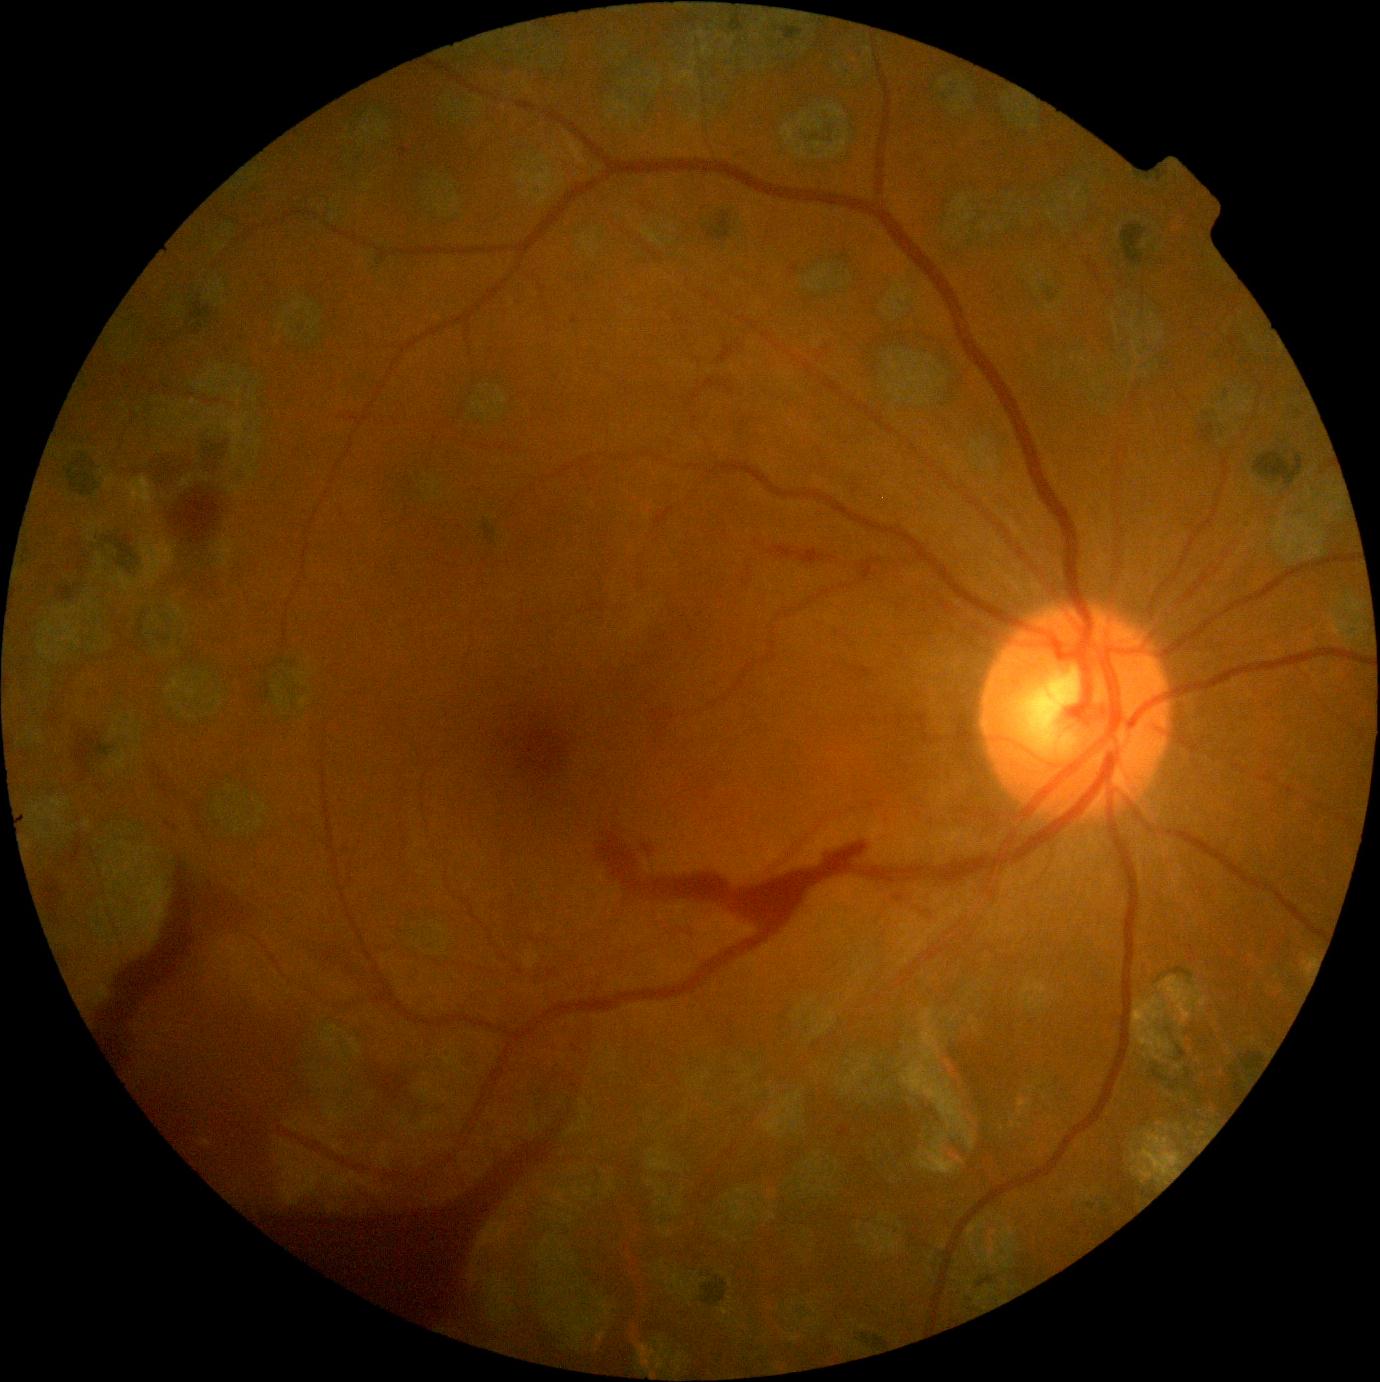
Annotations:
- diabetic retinopathy (DR) — grade 4